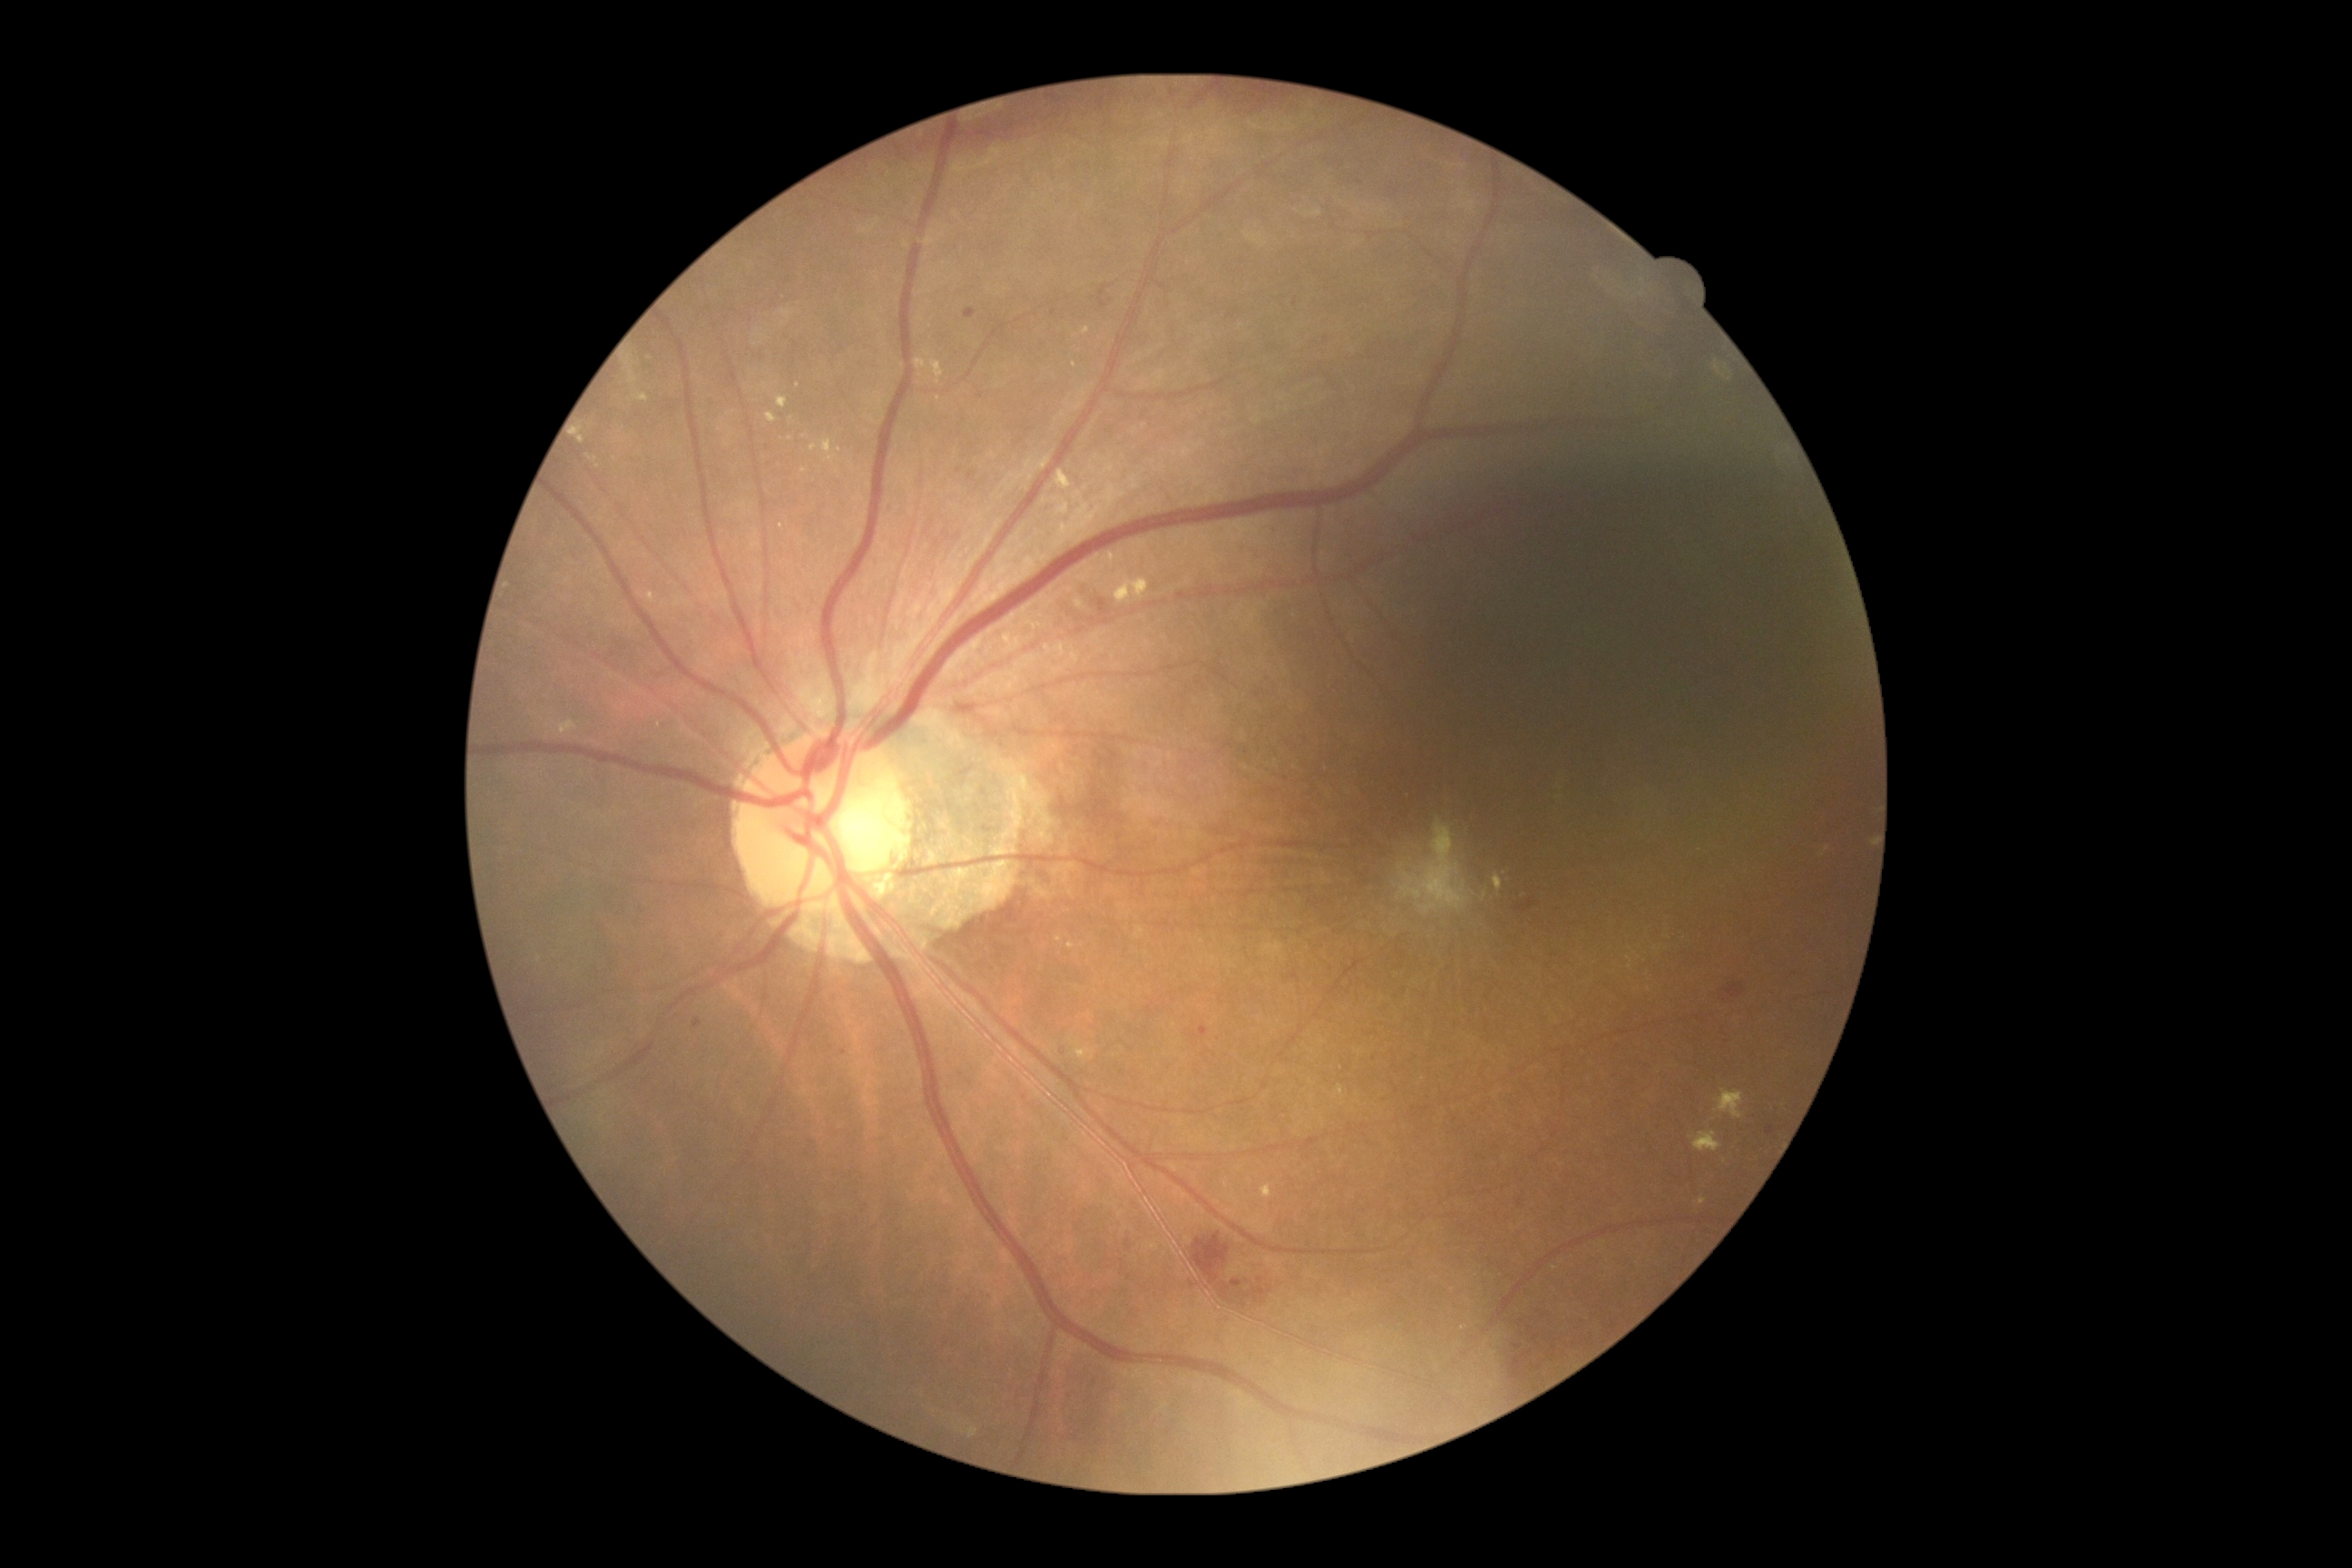
DR severity is grade 2 (moderate NPDR). EXs are present, including at bbox=[1055, 471, 1072, 491] | bbox=[1694, 1132, 1721, 1153] | bbox=[1083, 326, 1090, 337] | bbox=[778, 397, 789, 409] | bbox=[1041, 640, 1052, 656] | bbox=[1335, 1084, 1344, 1099] | bbox=[1054, 642, 1066, 656] | bbox=[776, 522, 790, 536] | bbox=[1075, 1043, 1095, 1061]. Additional small EXs near [x=596, y=460] | [x=1057, y=939] | [x=791, y=439] | [x=939, y=400] | [x=929, y=354].